NIDEK AFC-230 fundus camera, 45° FOV.
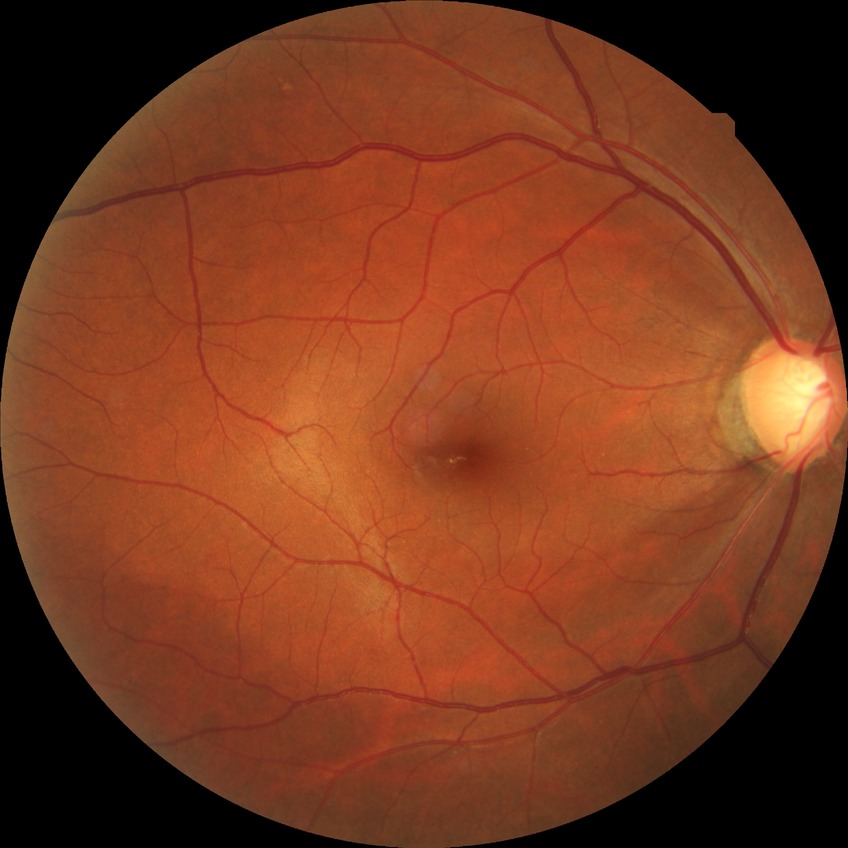 Diabetic retinopathy (DR): NDR (no diabetic retinopathy).